Wide-field fundus image from infant ROP screening — 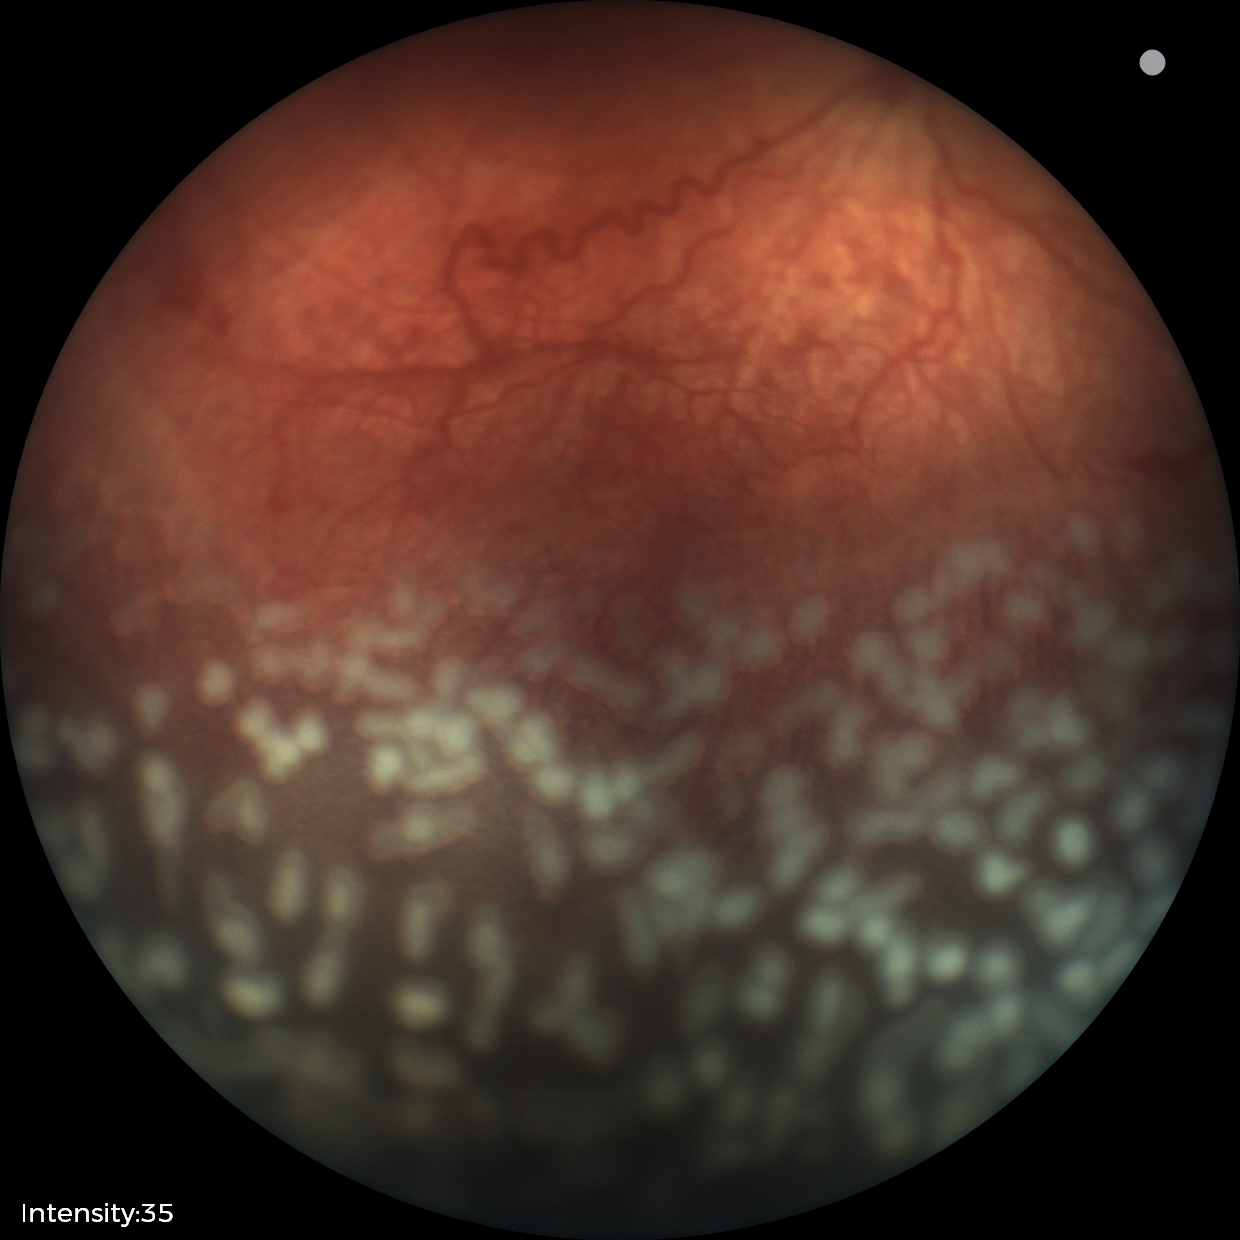
Assessment: ROP stage 2.